50° FOV
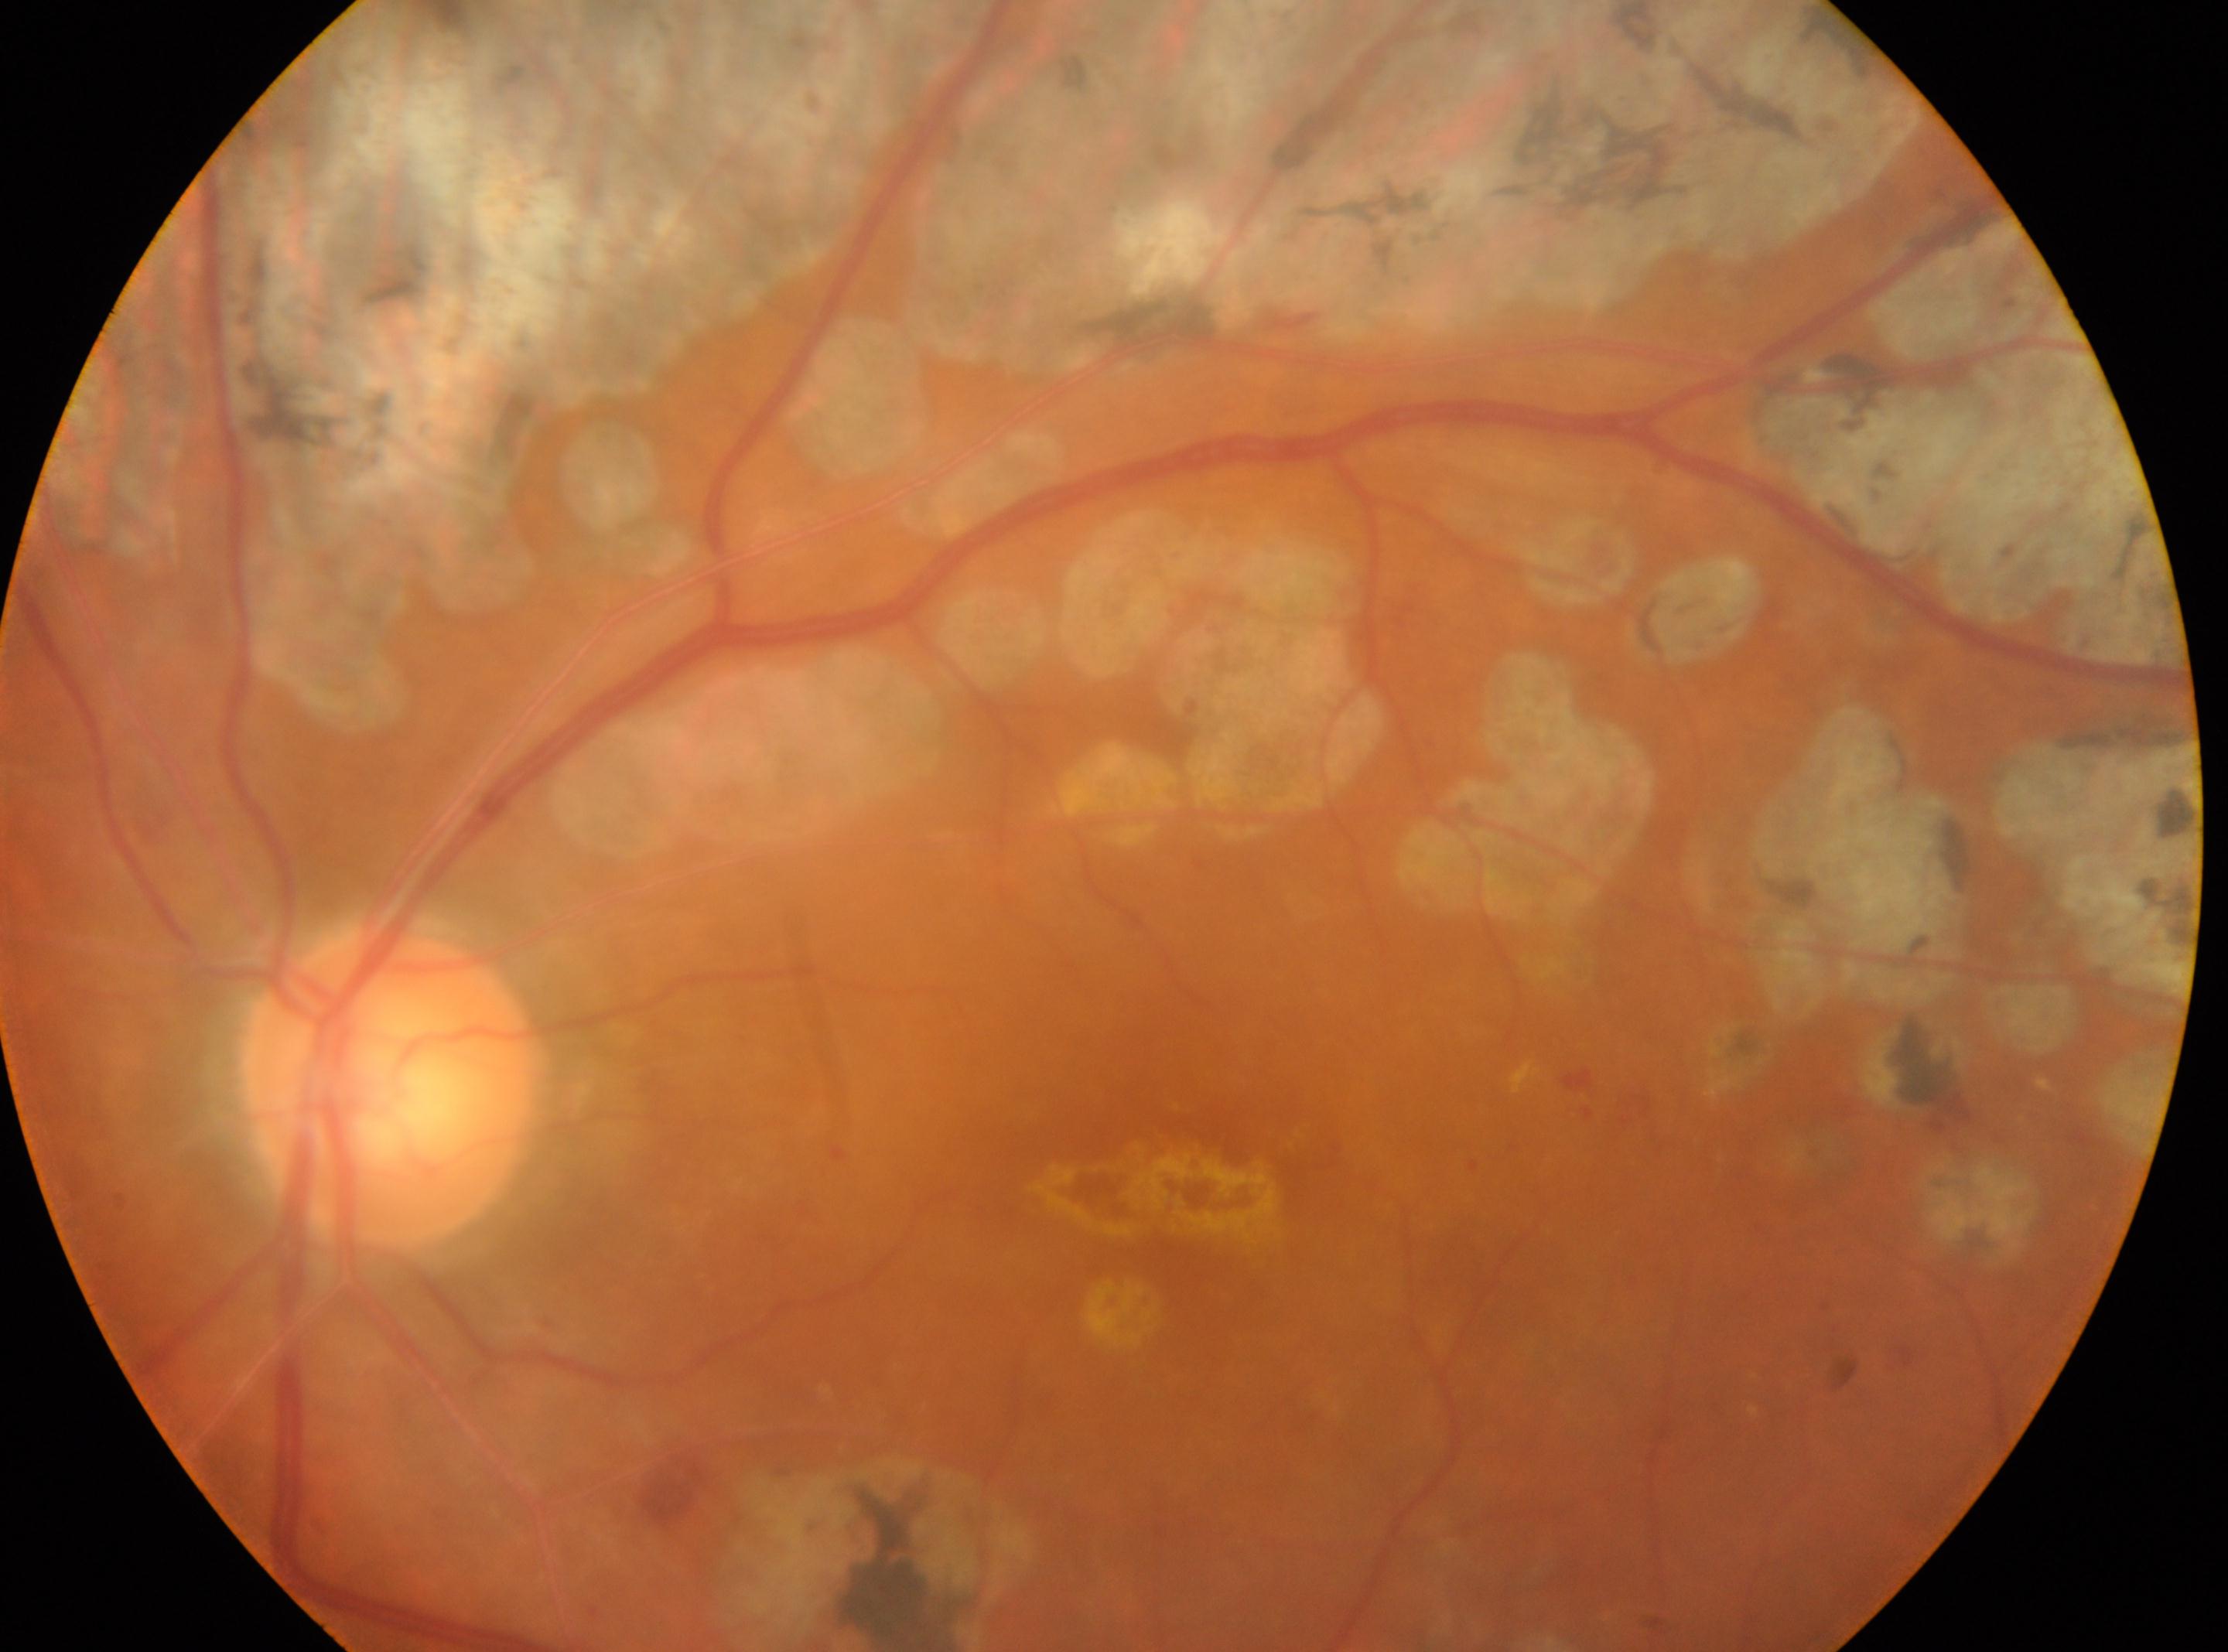 Findings:
- laterality: left eye
- the fovea: (1184, 1190)
- ONH: (390, 1087)
- DR: post-photocoagulation DR